Optic disc region crop. Non-mydriatic fundus camera
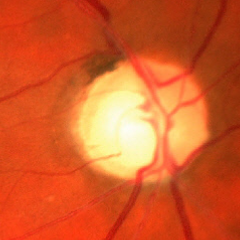 Glaucomatous changes are present. Findings consistent with advanced glaucoma. Defined as near-total cupping of the optic nerve head, with or without severe visual field loss within the central 10 degrees of fixation.